Davis DR grading. Without pupil dilation.
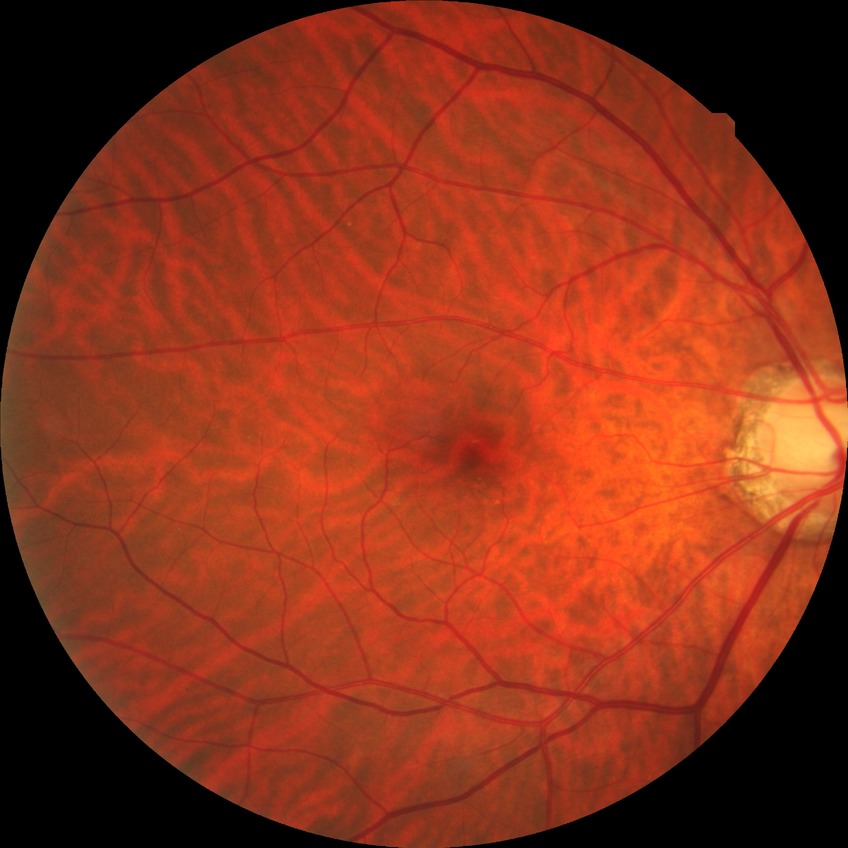

Modified Davis grading is no diabetic retinopathy.